Color fundus photograph
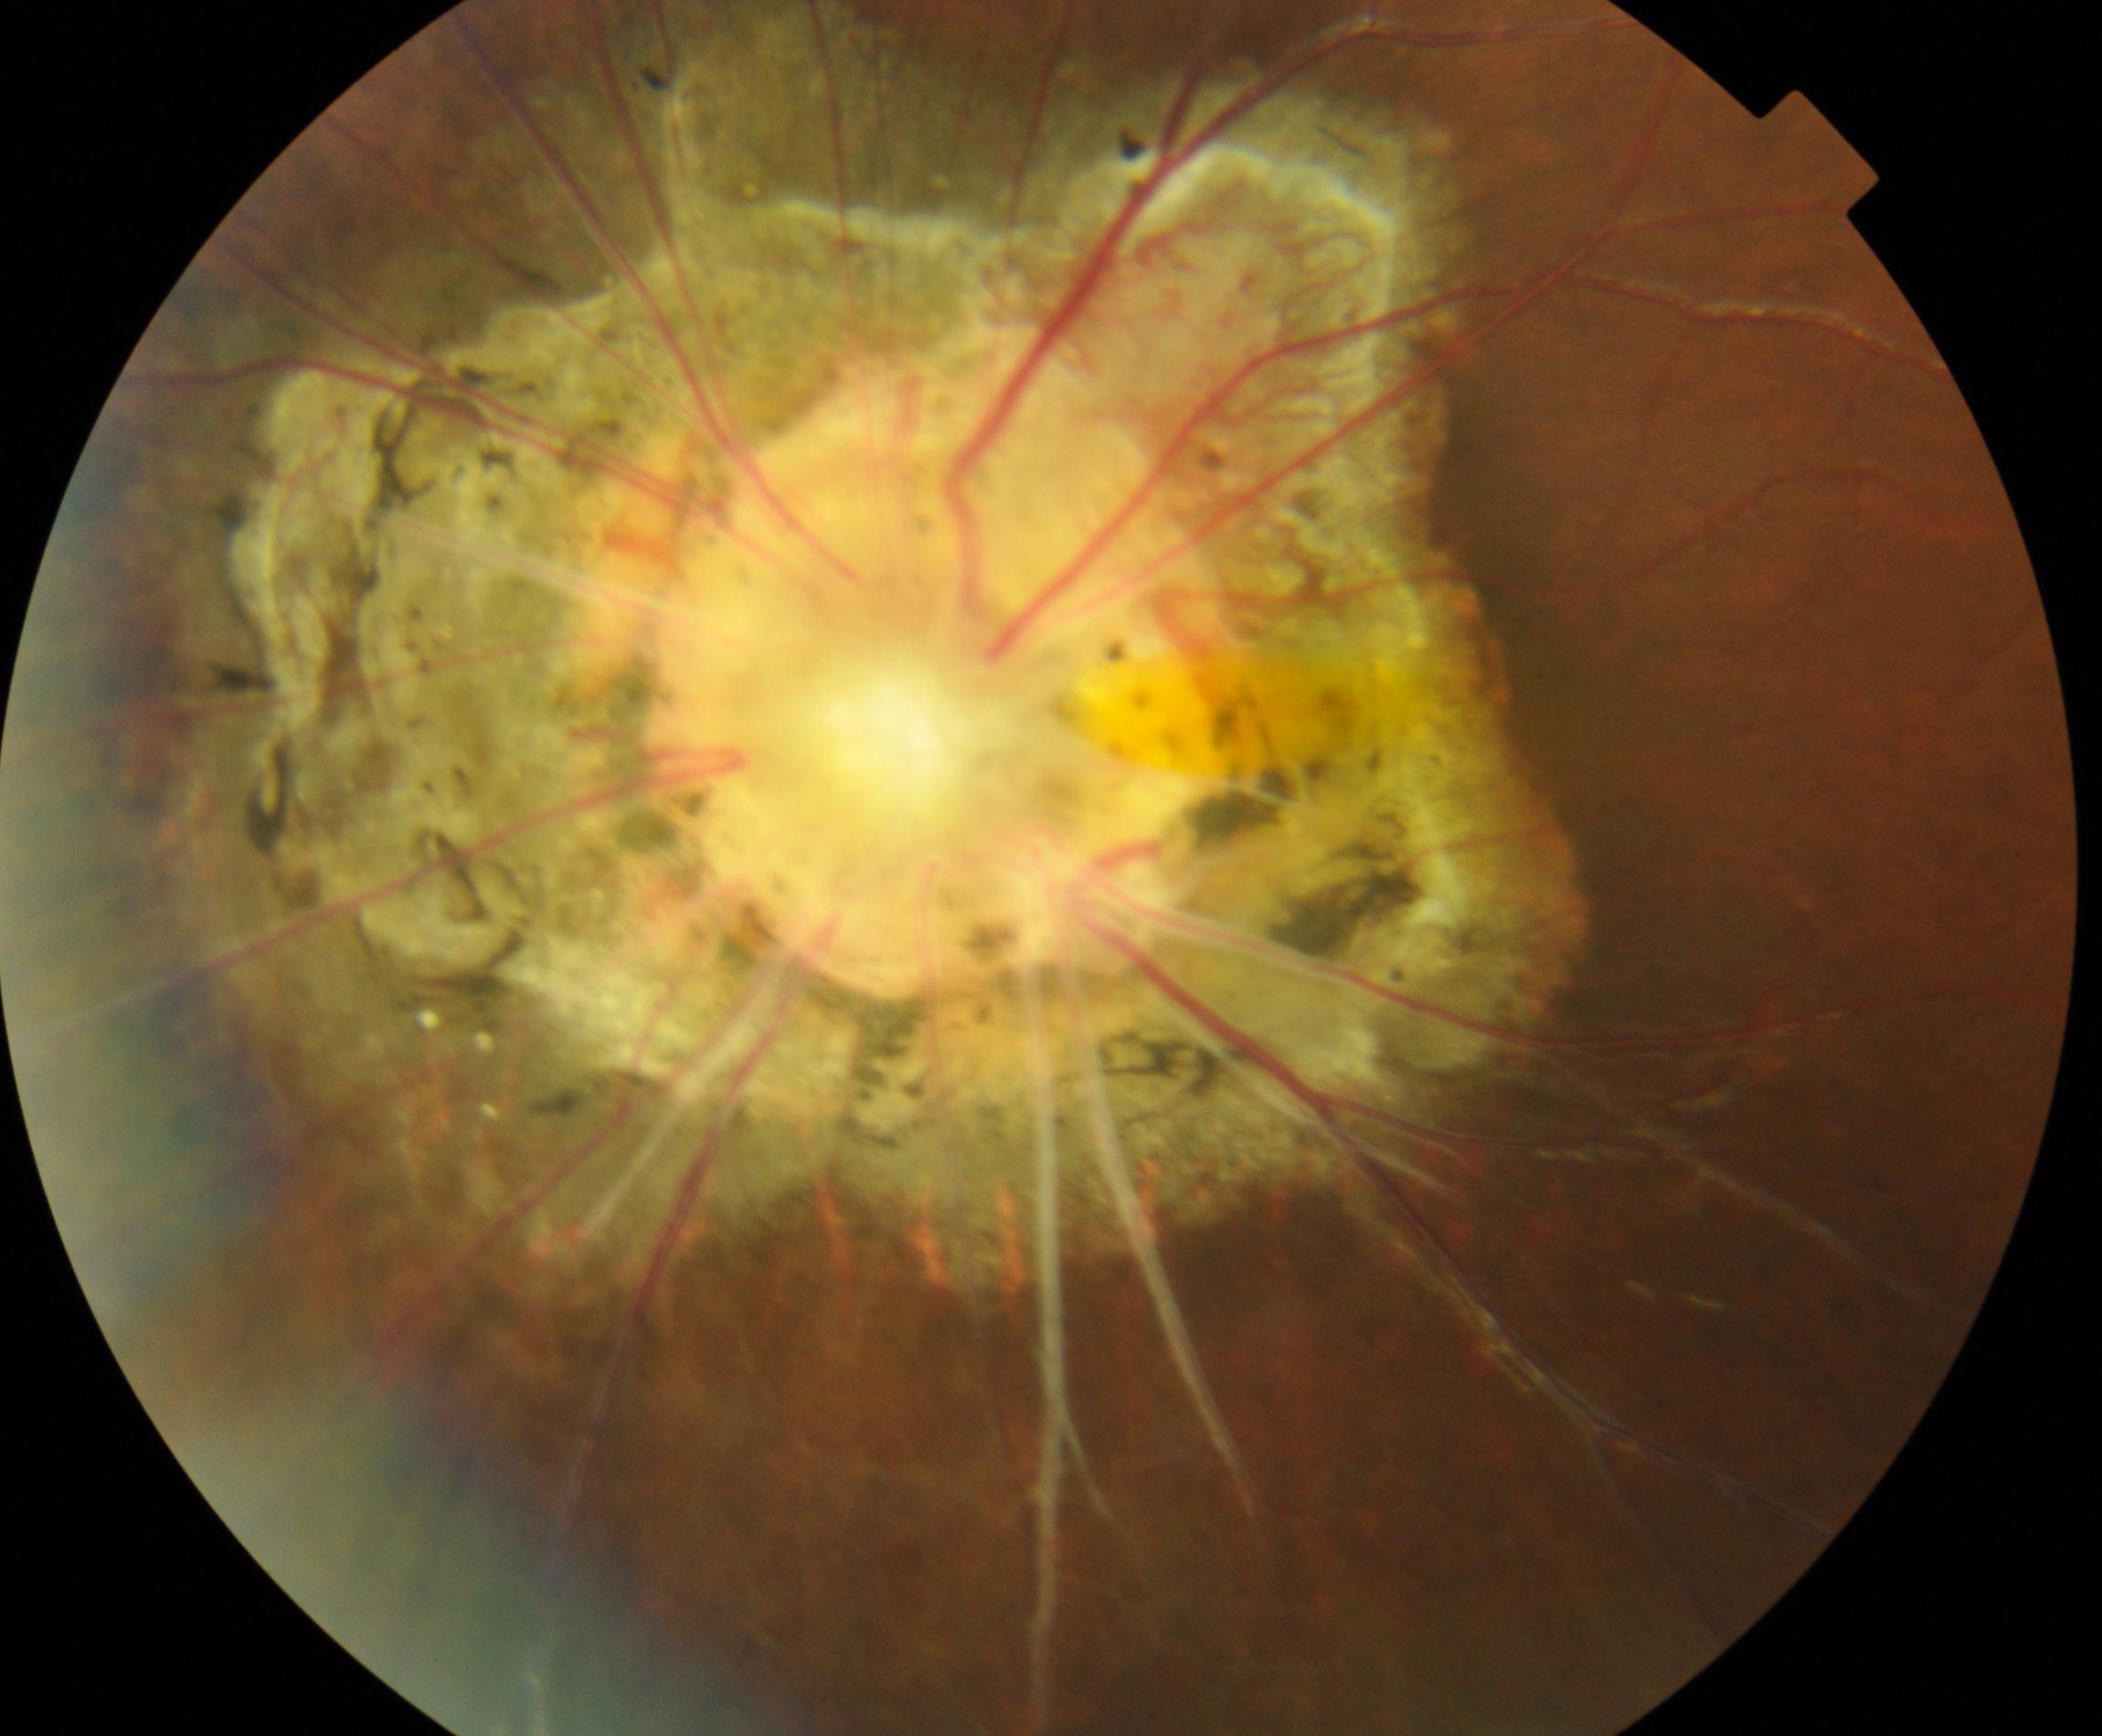

Diagnosis: congenital disc abnormality.